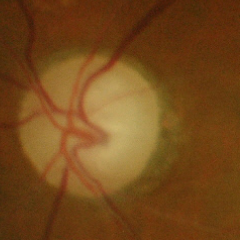
Glaucomatous changes are present.
Severe glaucomatous damage.